Color fundus photograph — 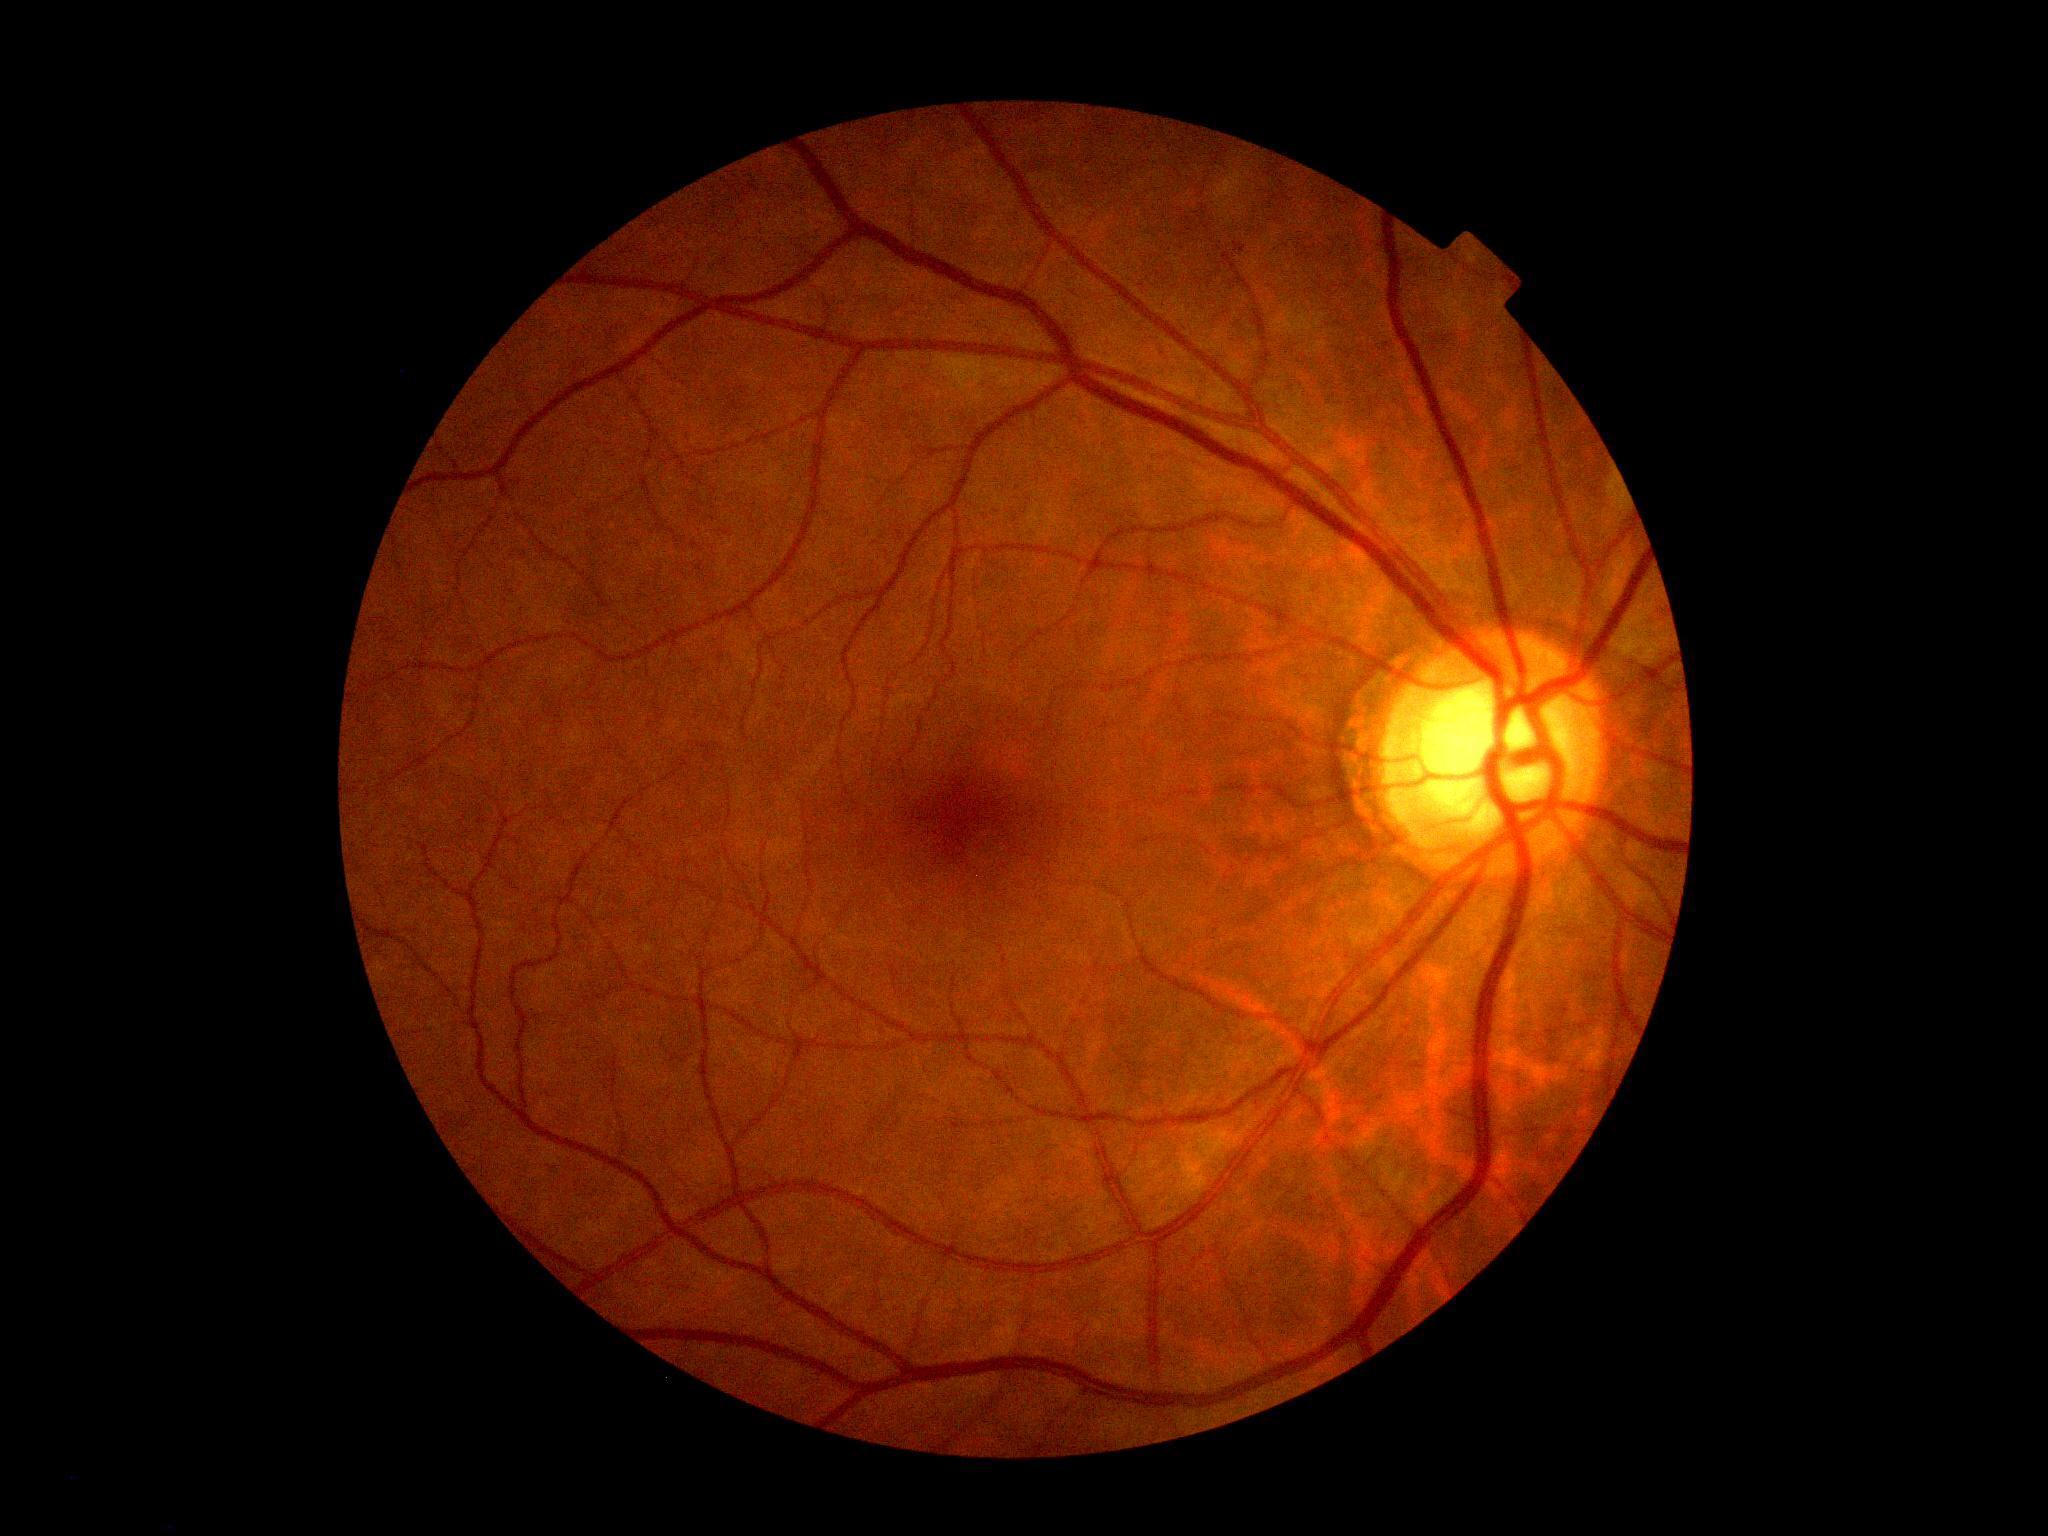
Diabetic retinopathy (DR): 1/4 — presence of microaneurysms only.